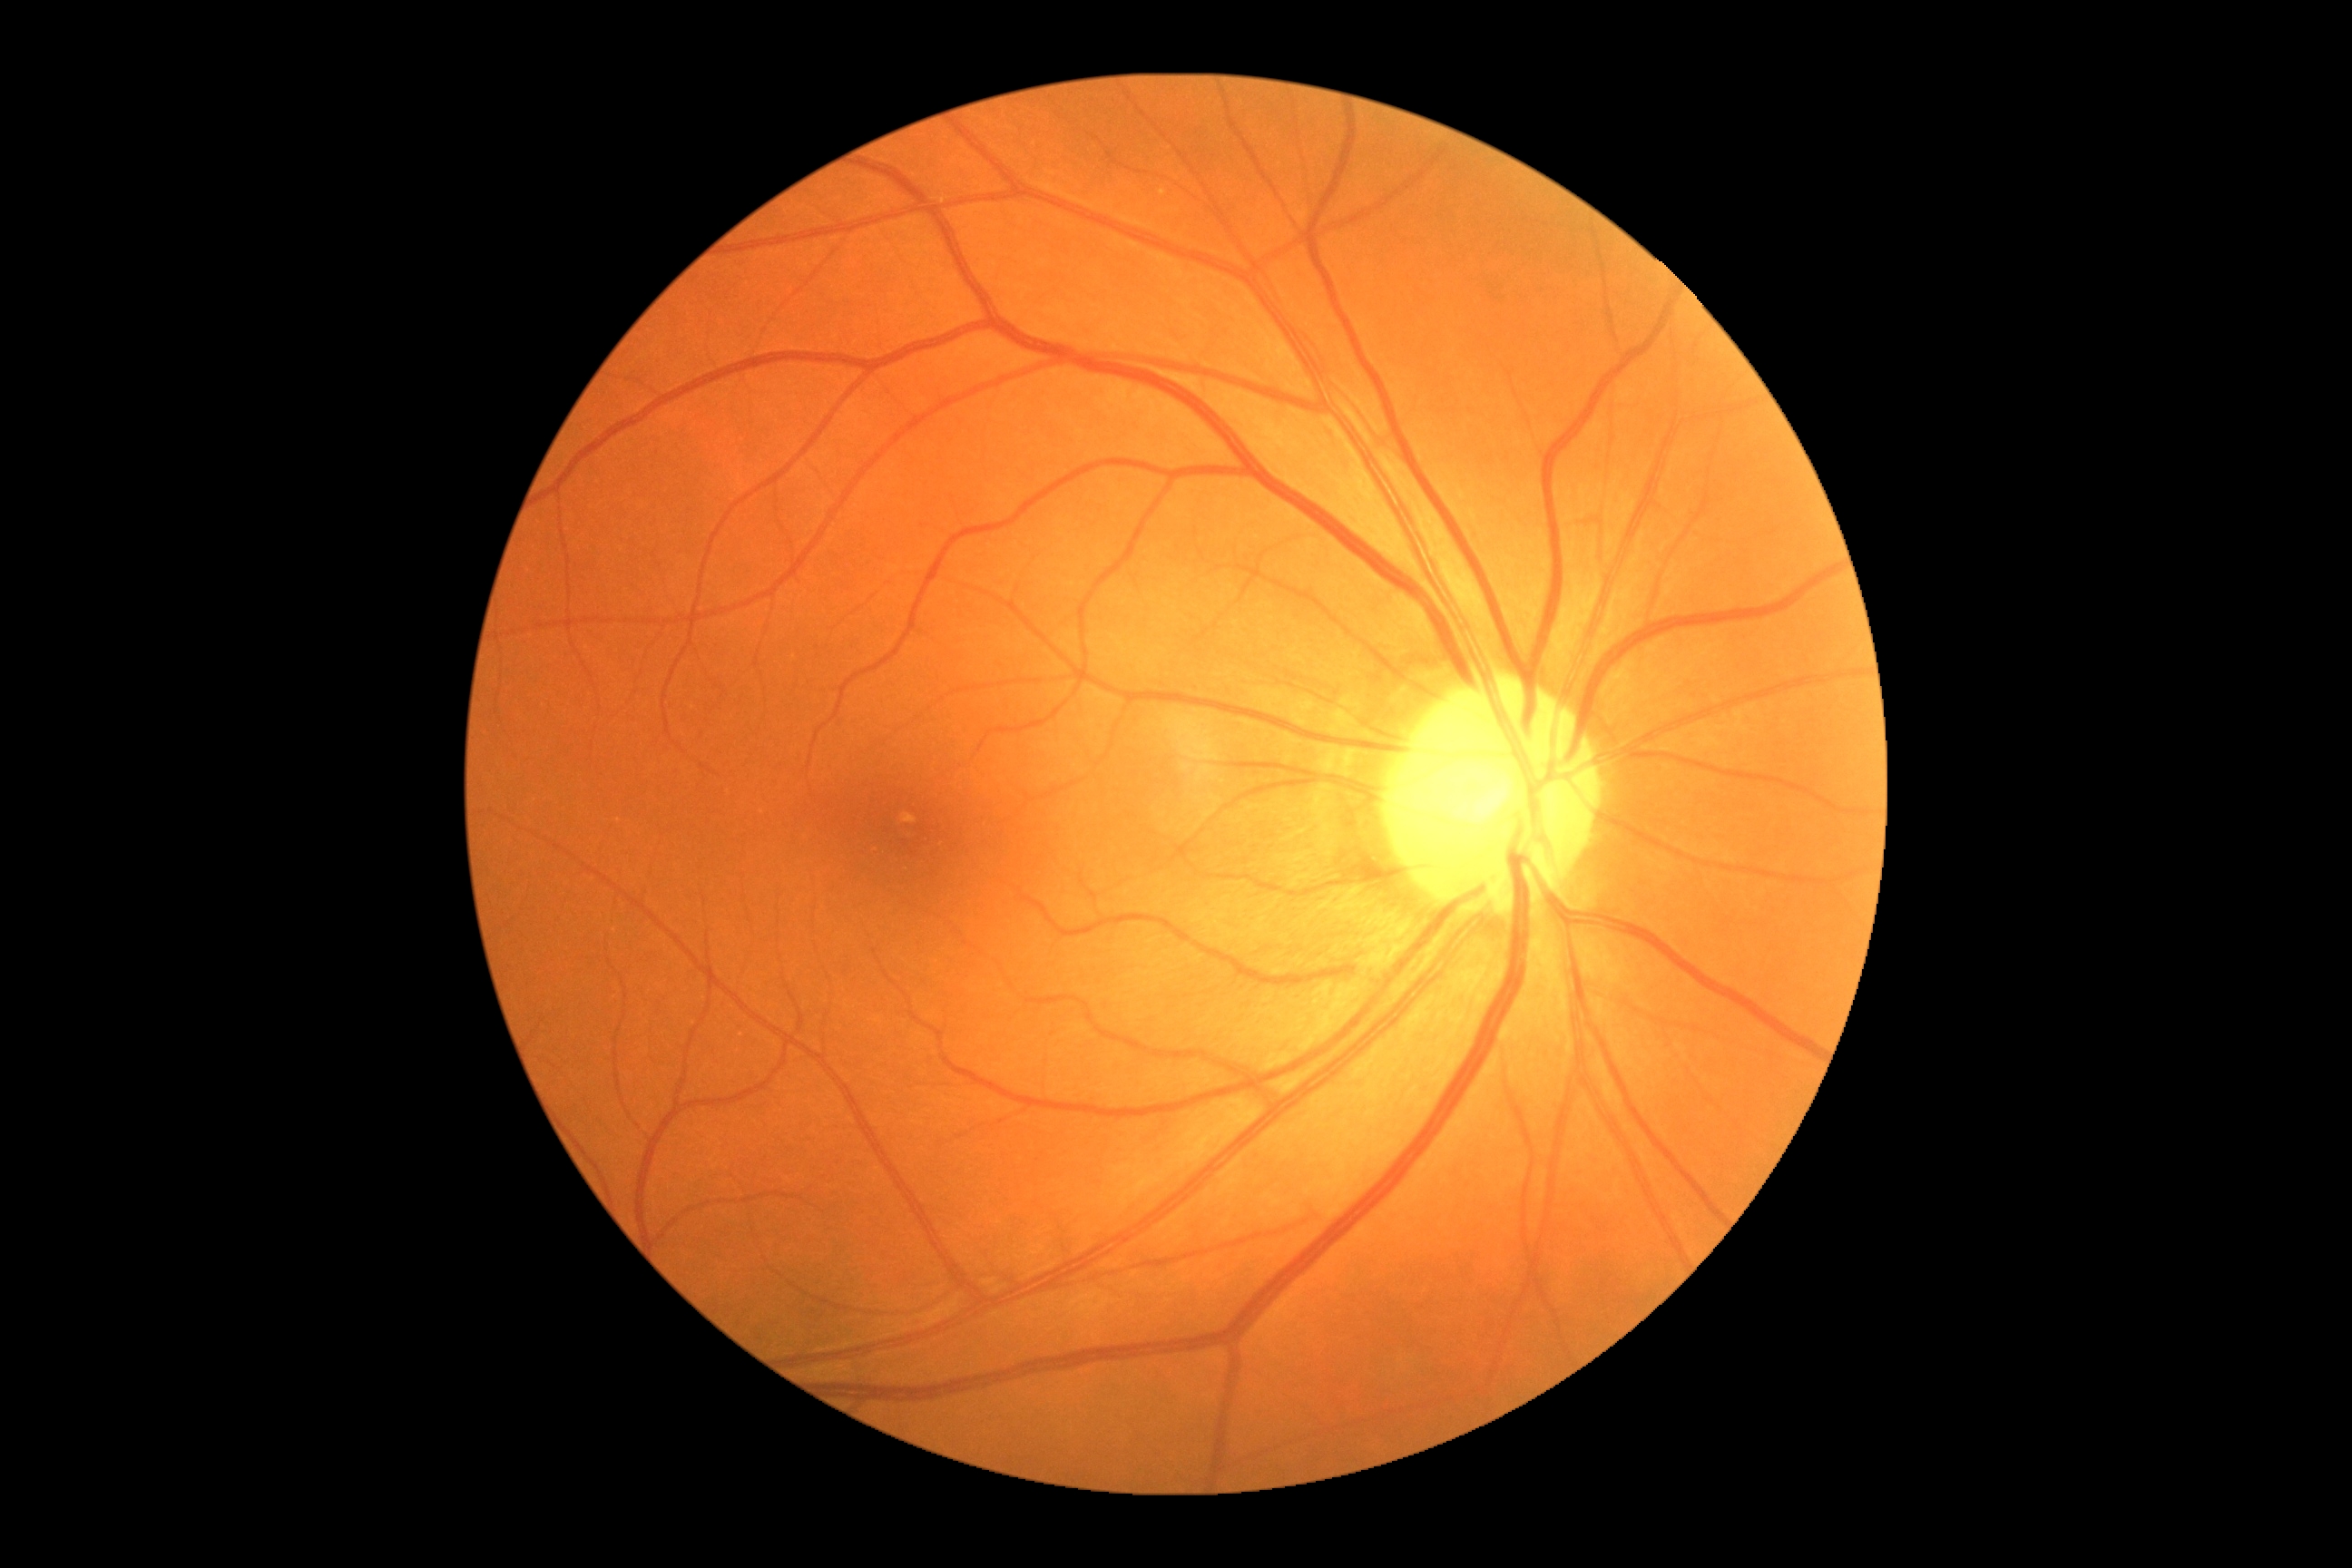

No signs of diabetic retinopathy.
Diabetic retinopathy (DR) is no apparent retinopathy (grade 0) — no visible signs of diabetic retinopathy.